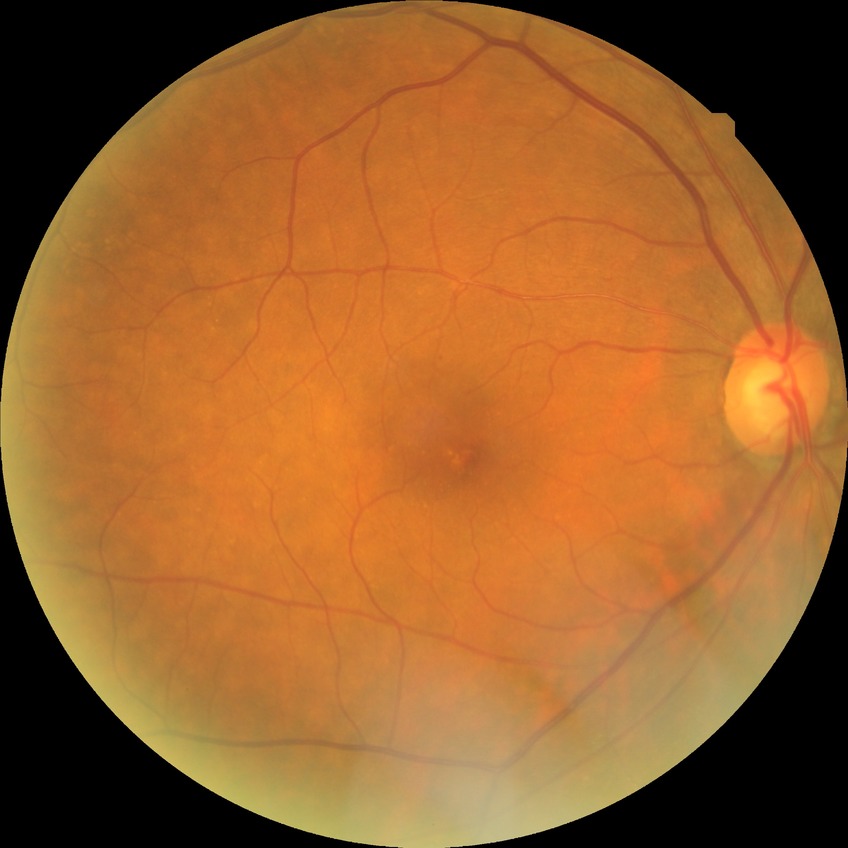
DR is NDR.